Image size 2352x1568 — 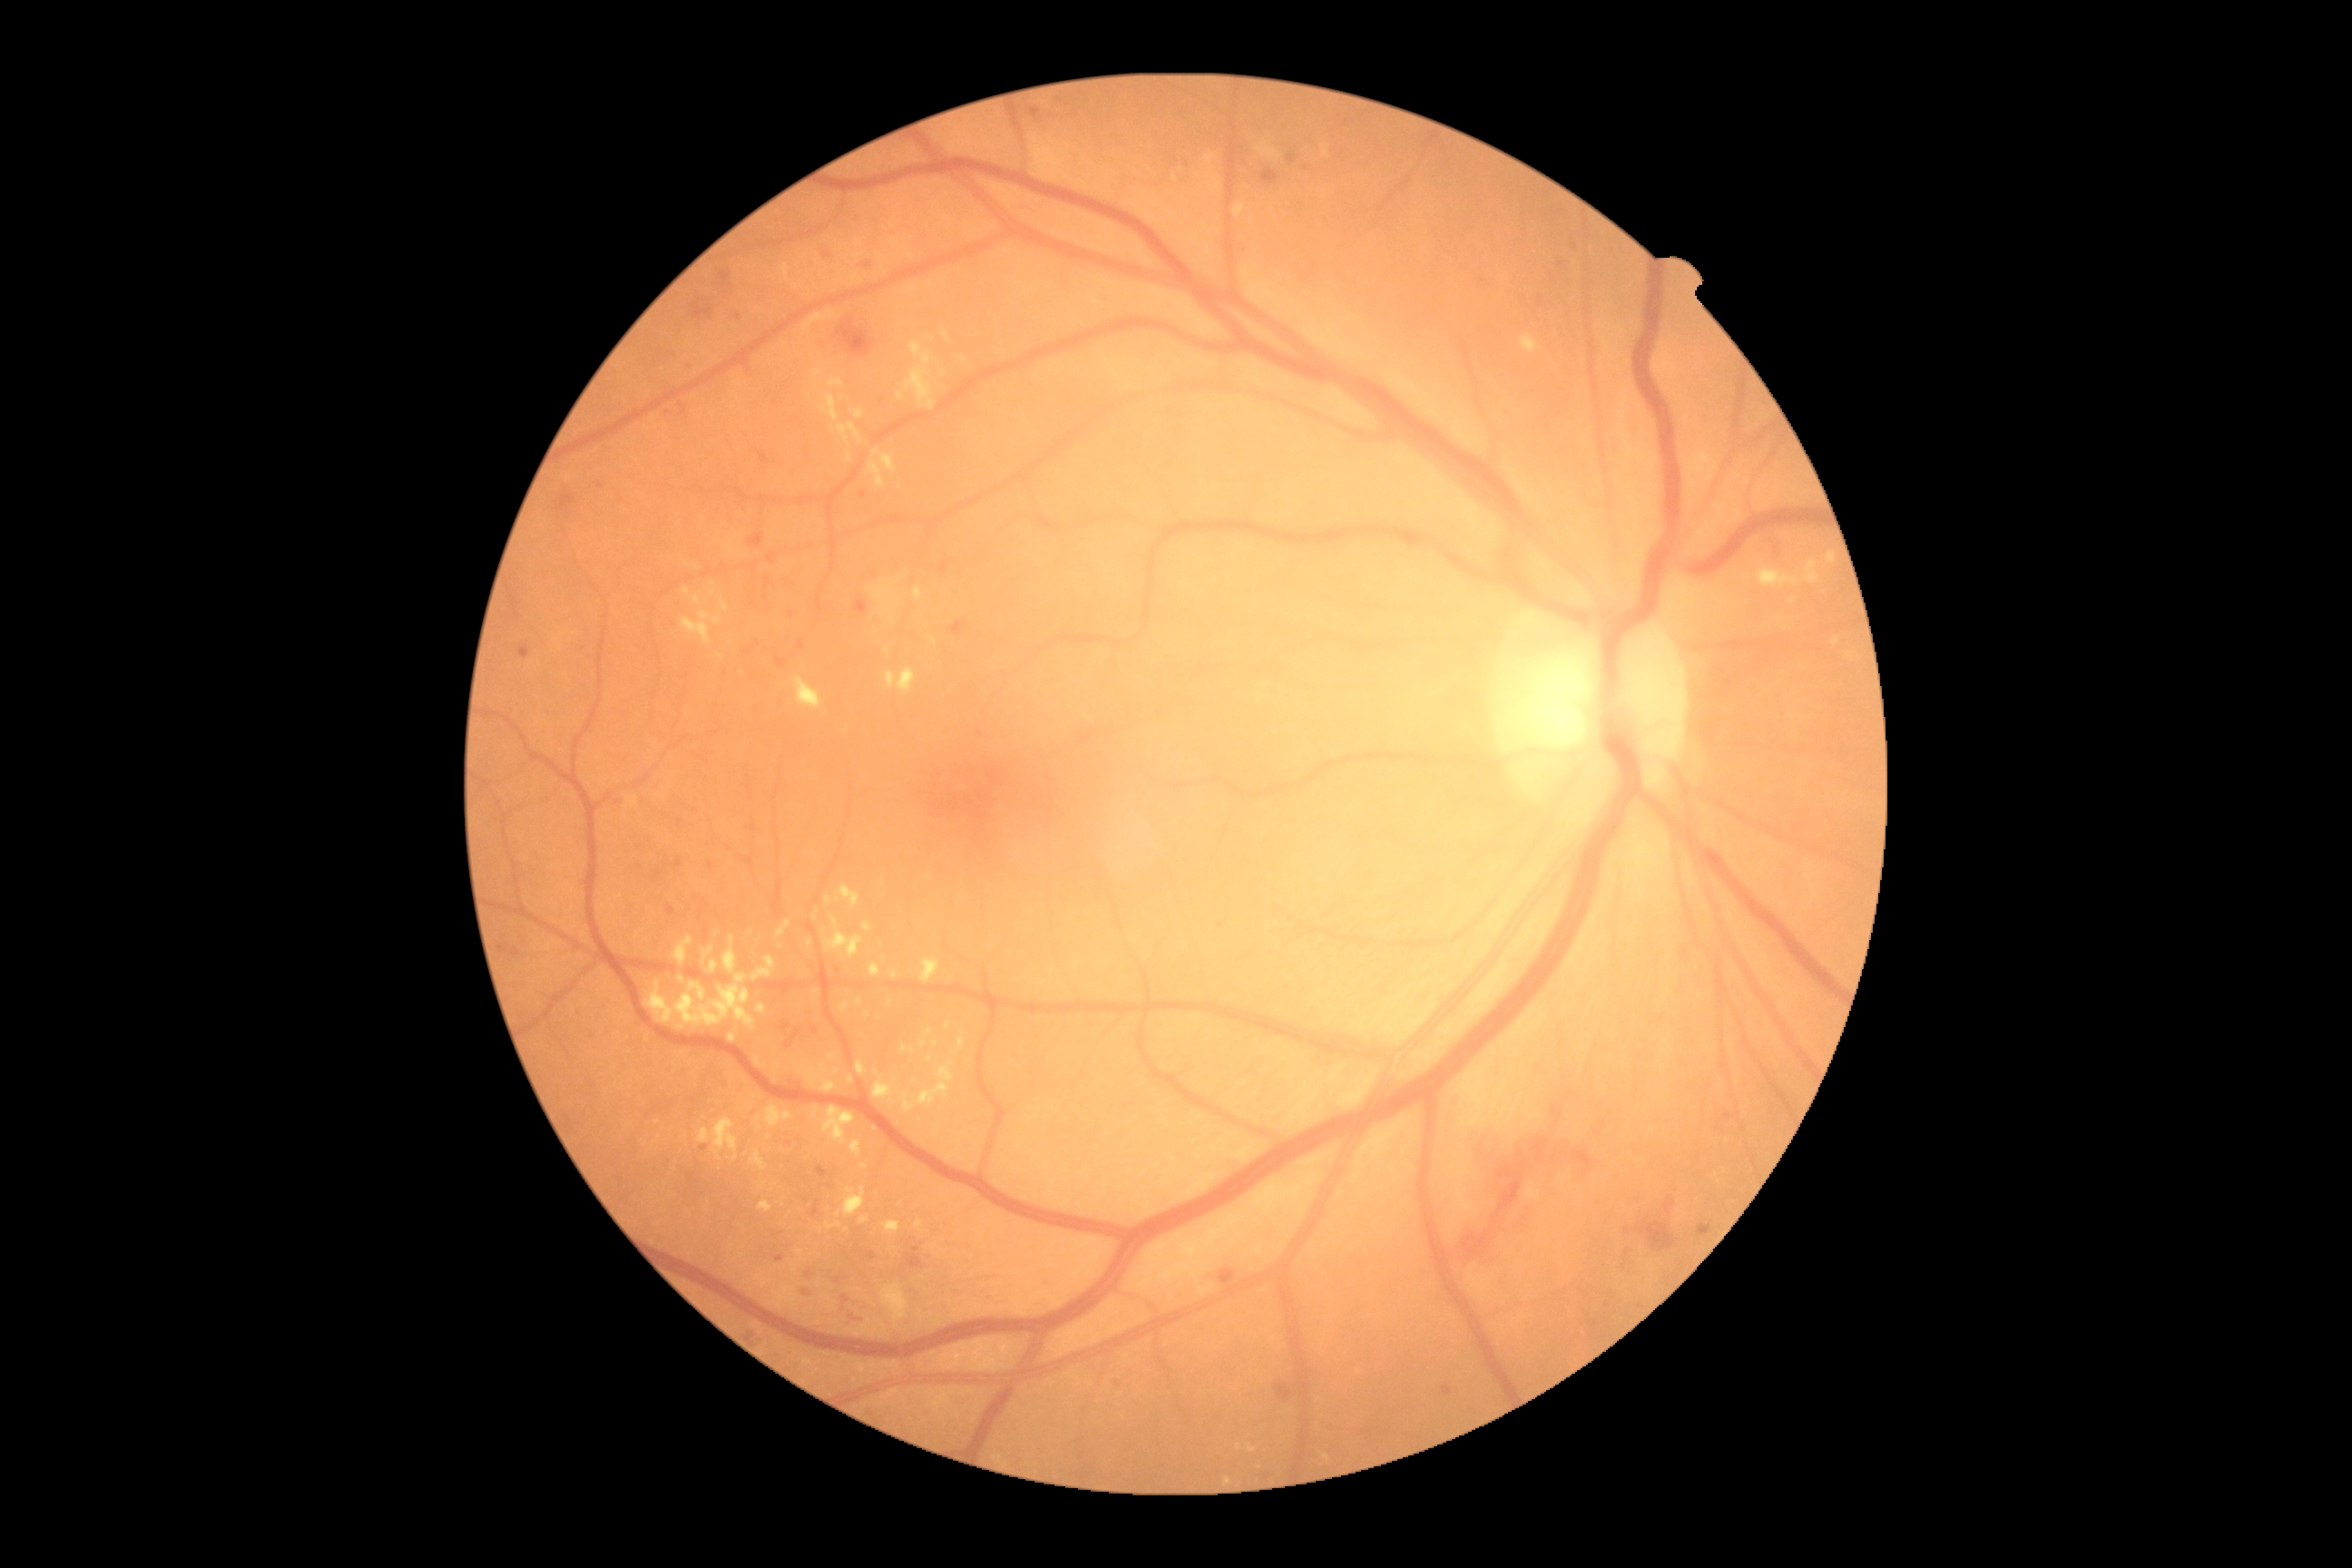 DR grade: severe NPDR (3).